Infant wide-field fundus photograph: 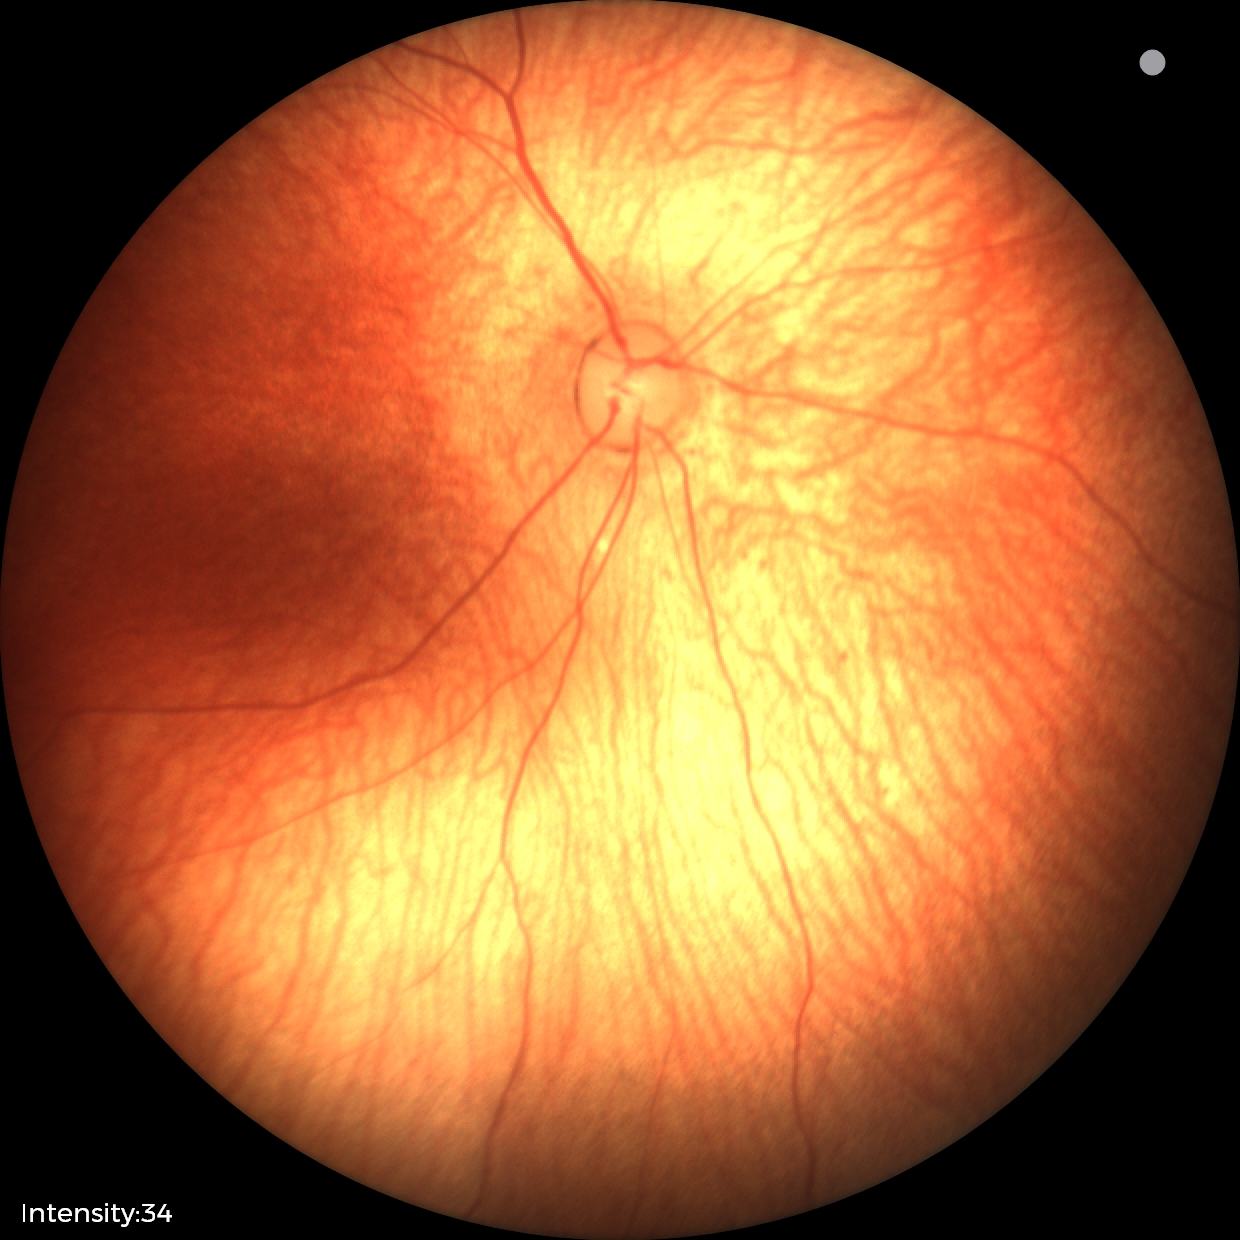
Physiological retinal appearance for postconceptual age.